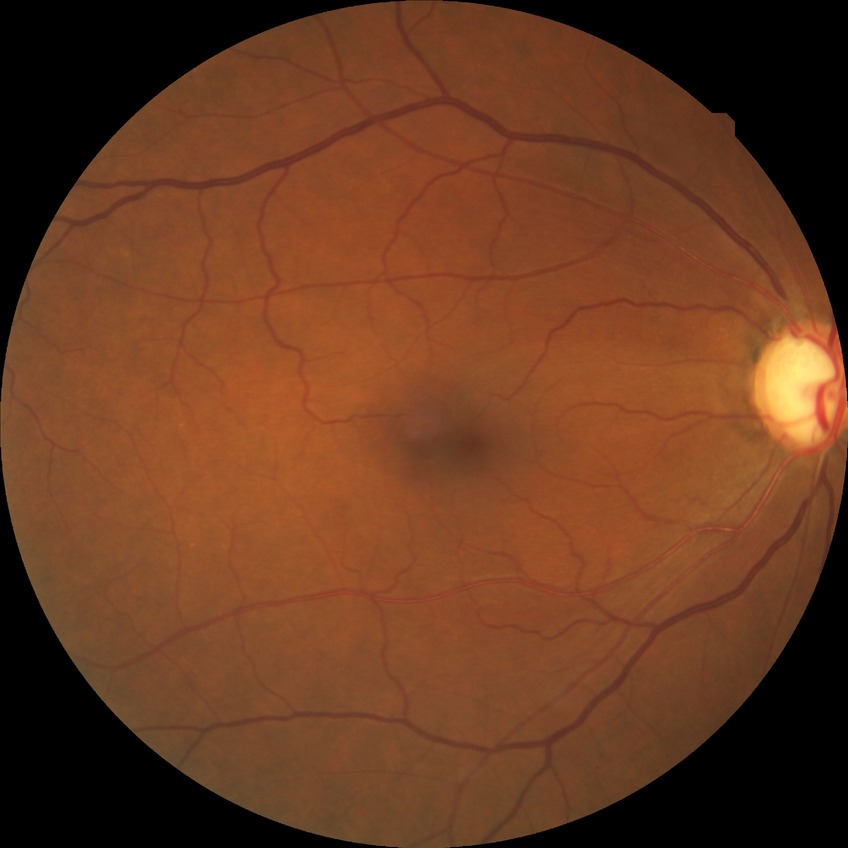 Assessment:
• diabetic retinopathy (DR) — no diabetic retinopathy (NDR)